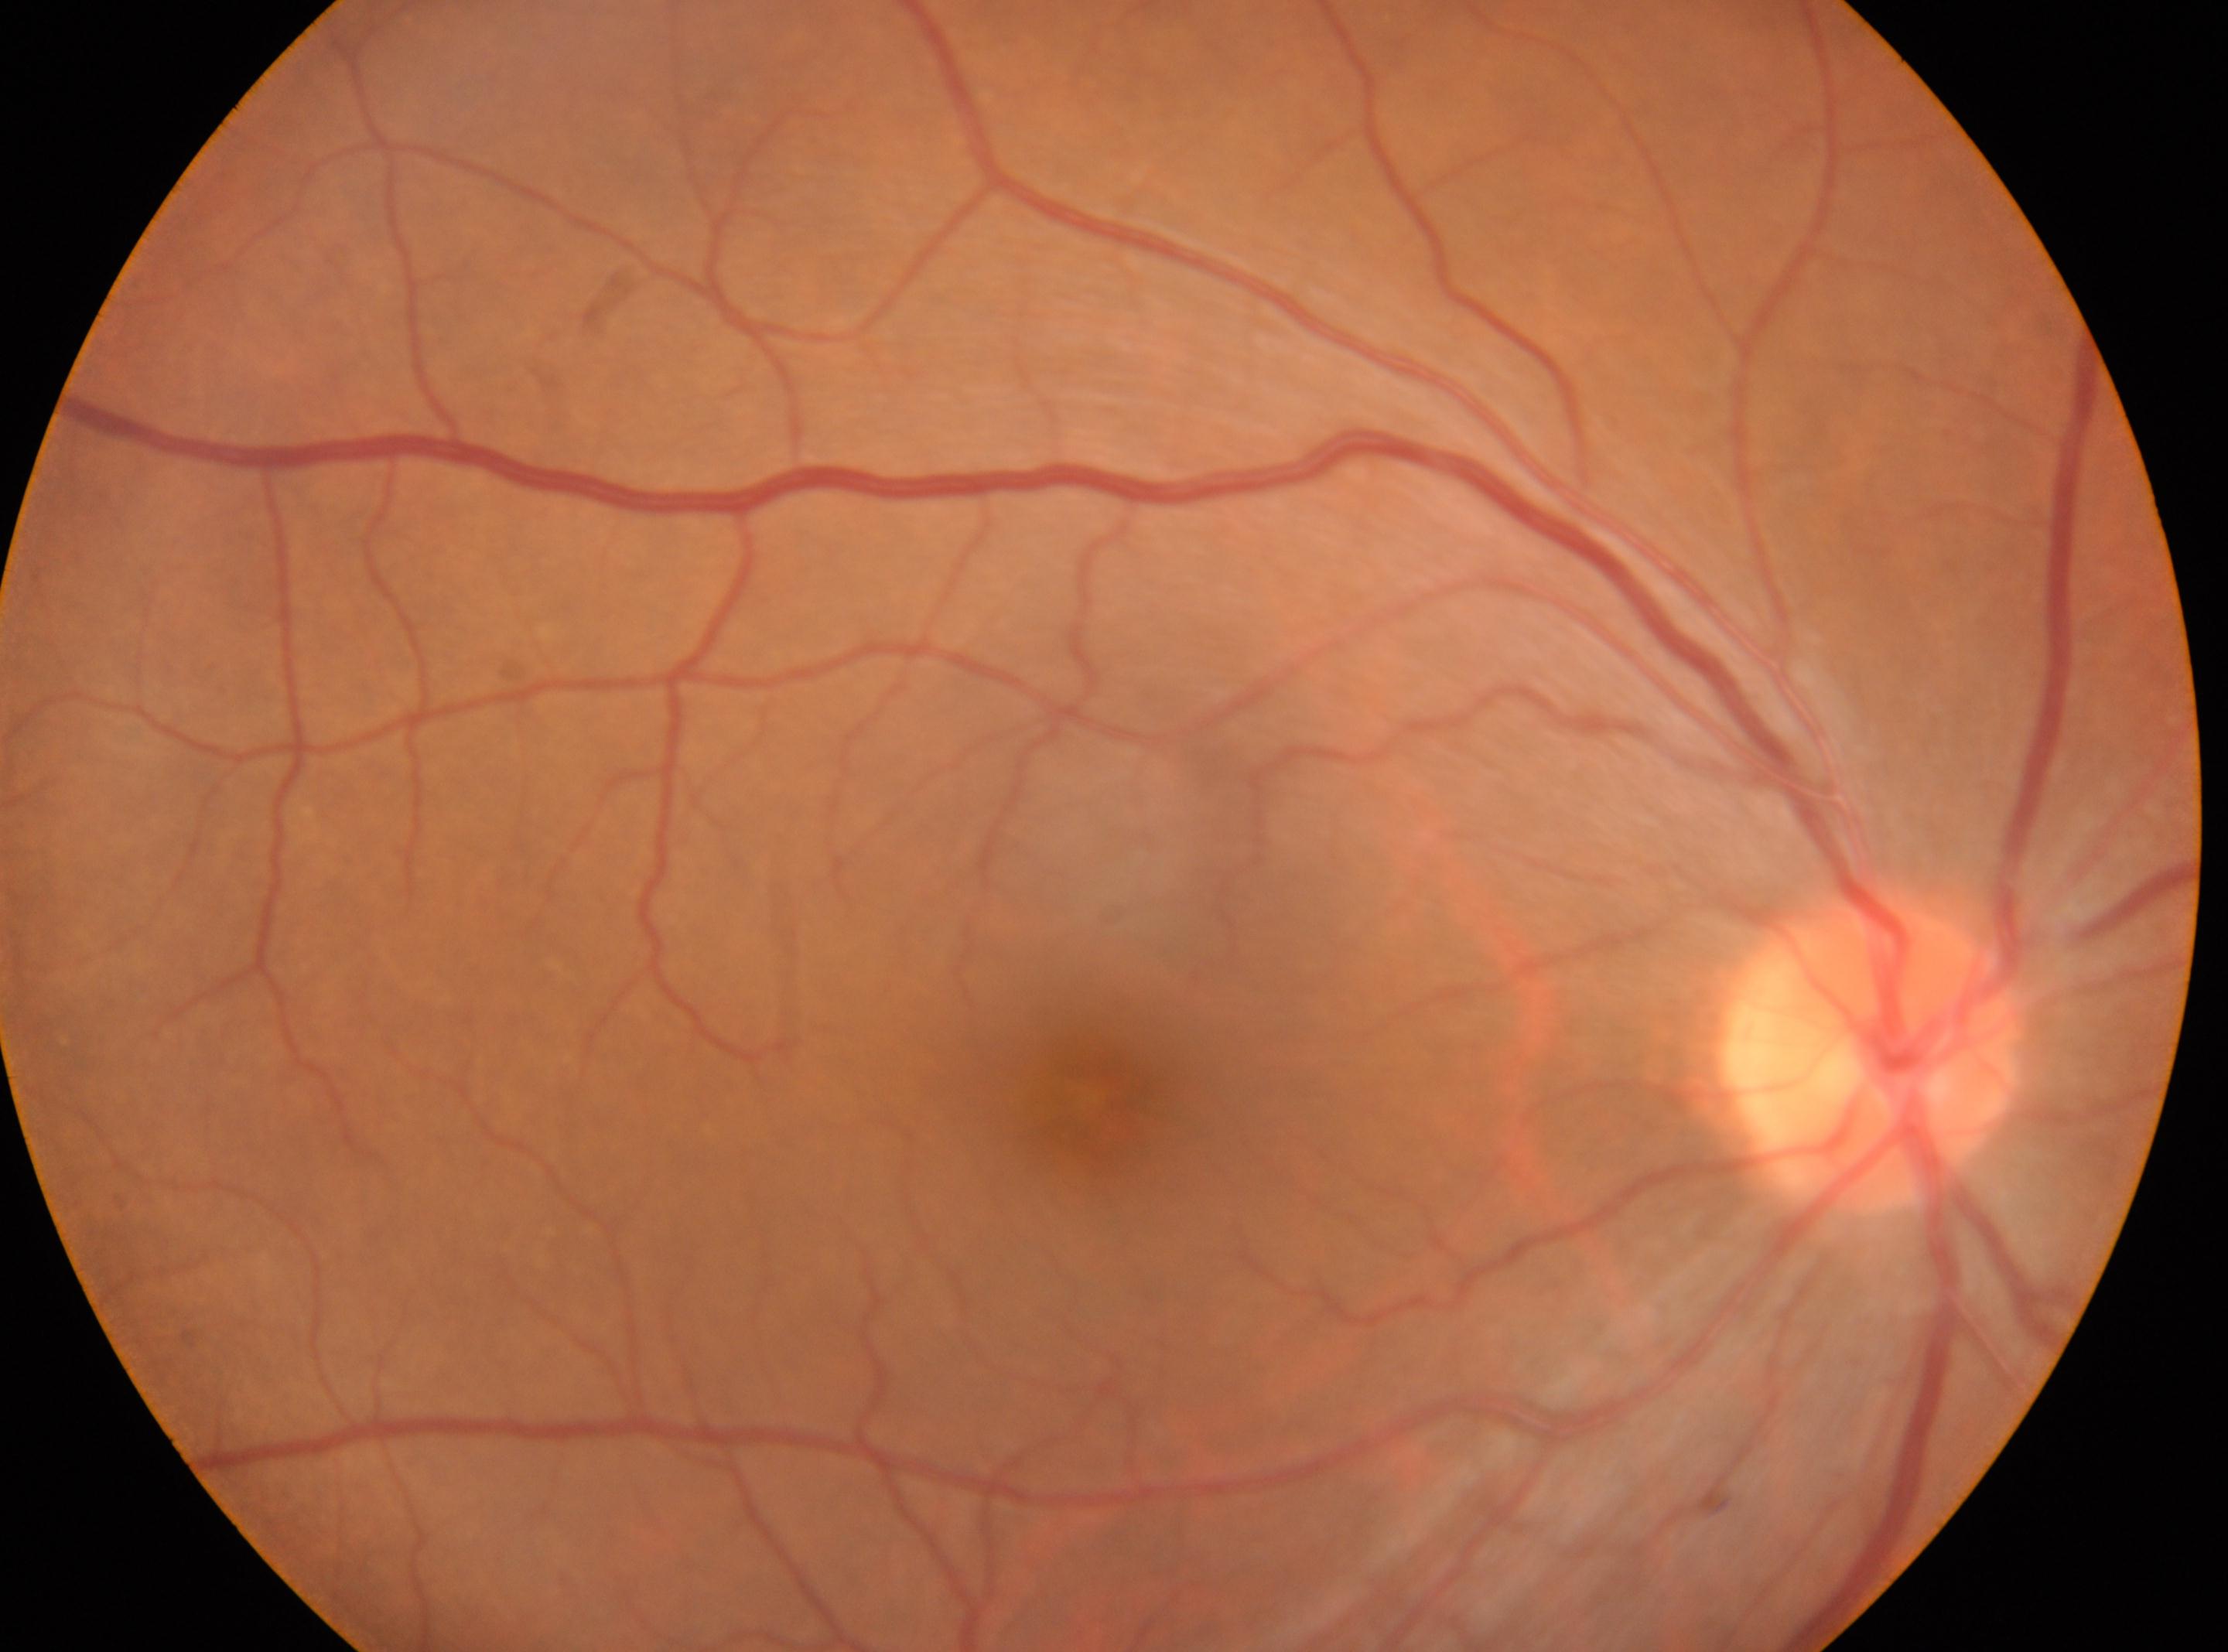 | field | value |
|---|---|
| DR impression | No diabetic retinopathy identified |
| foveal center | (x: 1094, y: 1098) |
| diabetic retinopathy (DR) | no apparent retinopathy (grade 0) |
| eye | OD |
| disc center | (x: 1872, y: 1055) |